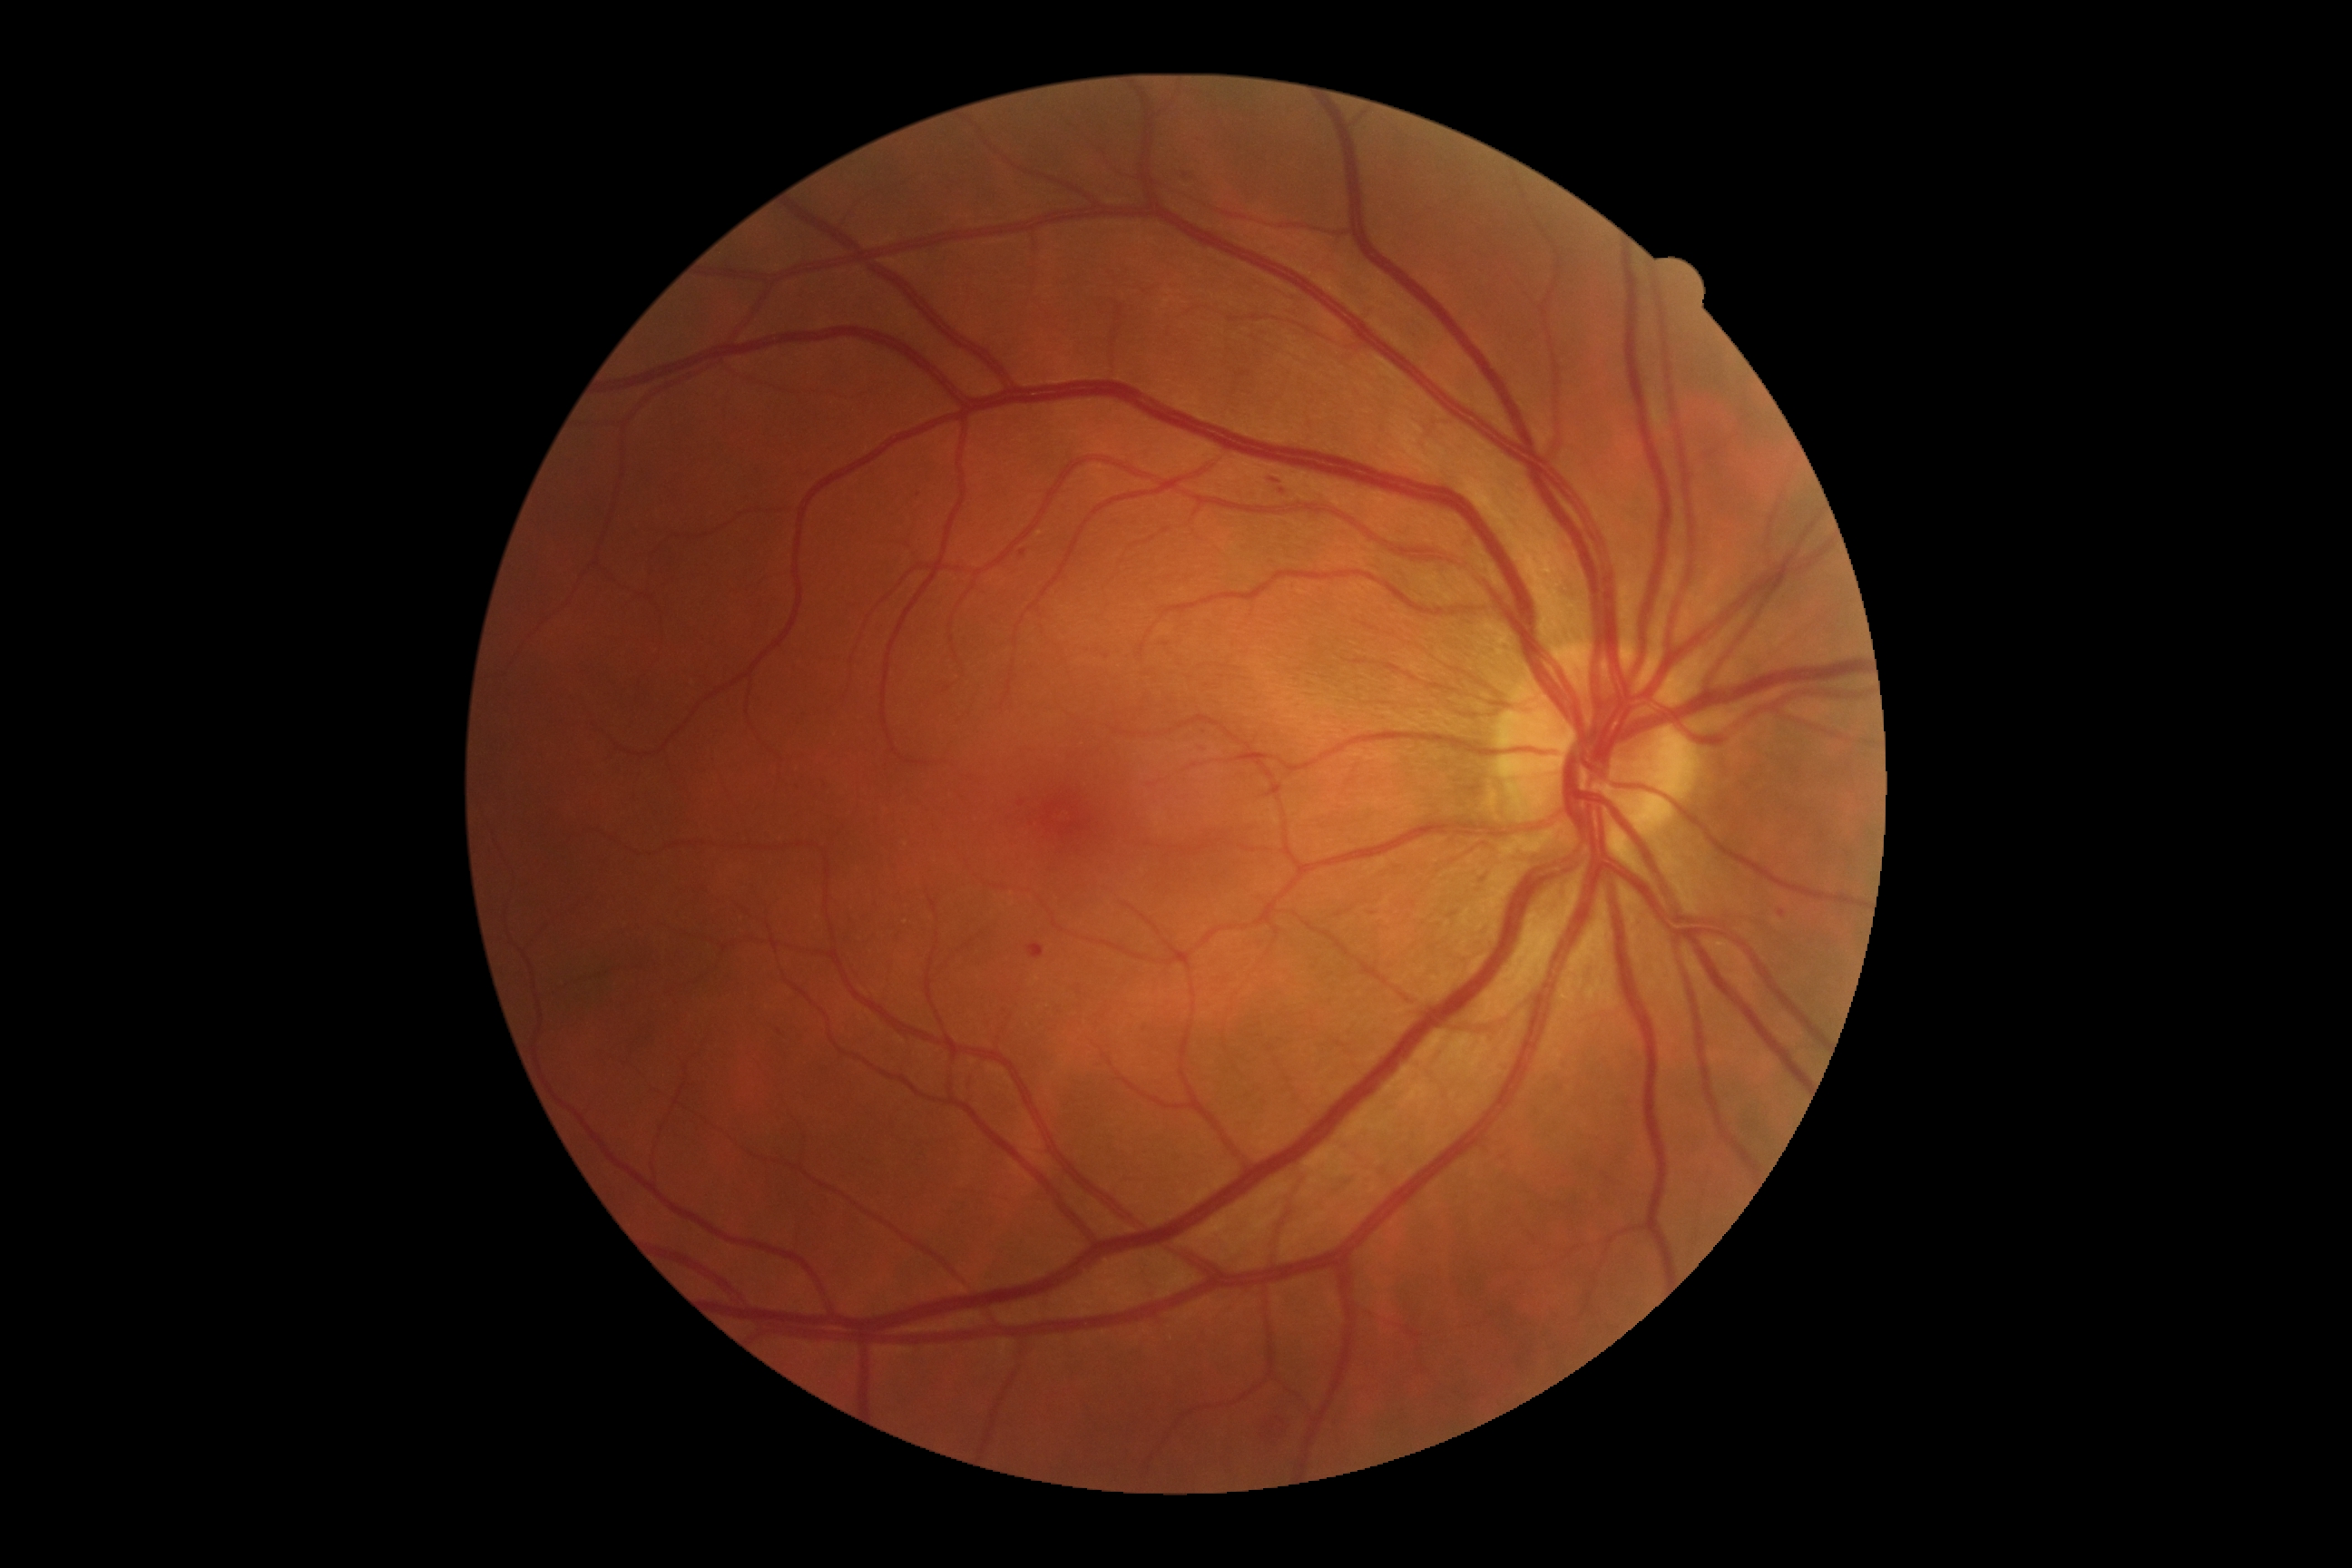 DR grade is 2 (moderate NPDR).